Captured with the Clarity RetCam 3 (130° field of view). Image size 640x480. Wide-field contact fundus photograph of an infant: 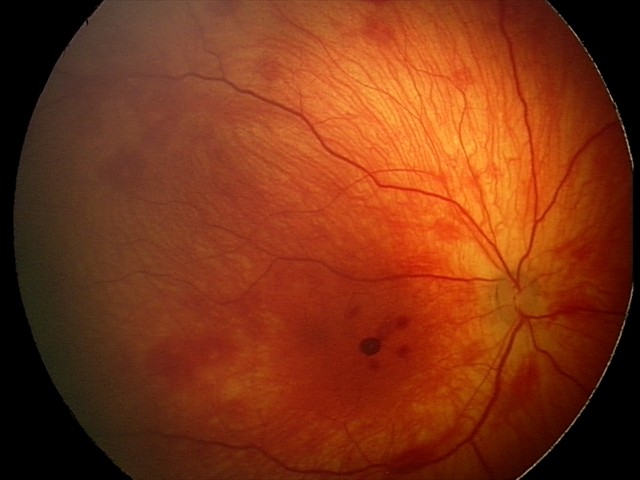
Assessment = retinal hemorrhages